45 degree fundus photograph · CFP:
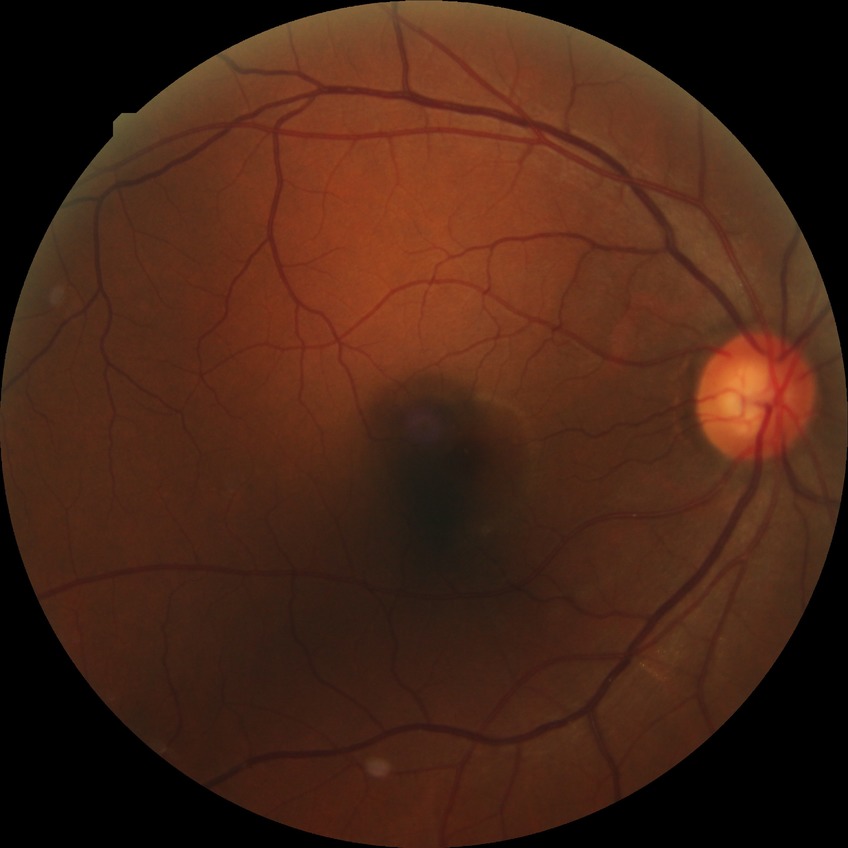

Modified Davis classification: no diabetic retinopathy.